1960 by 1897 pixels
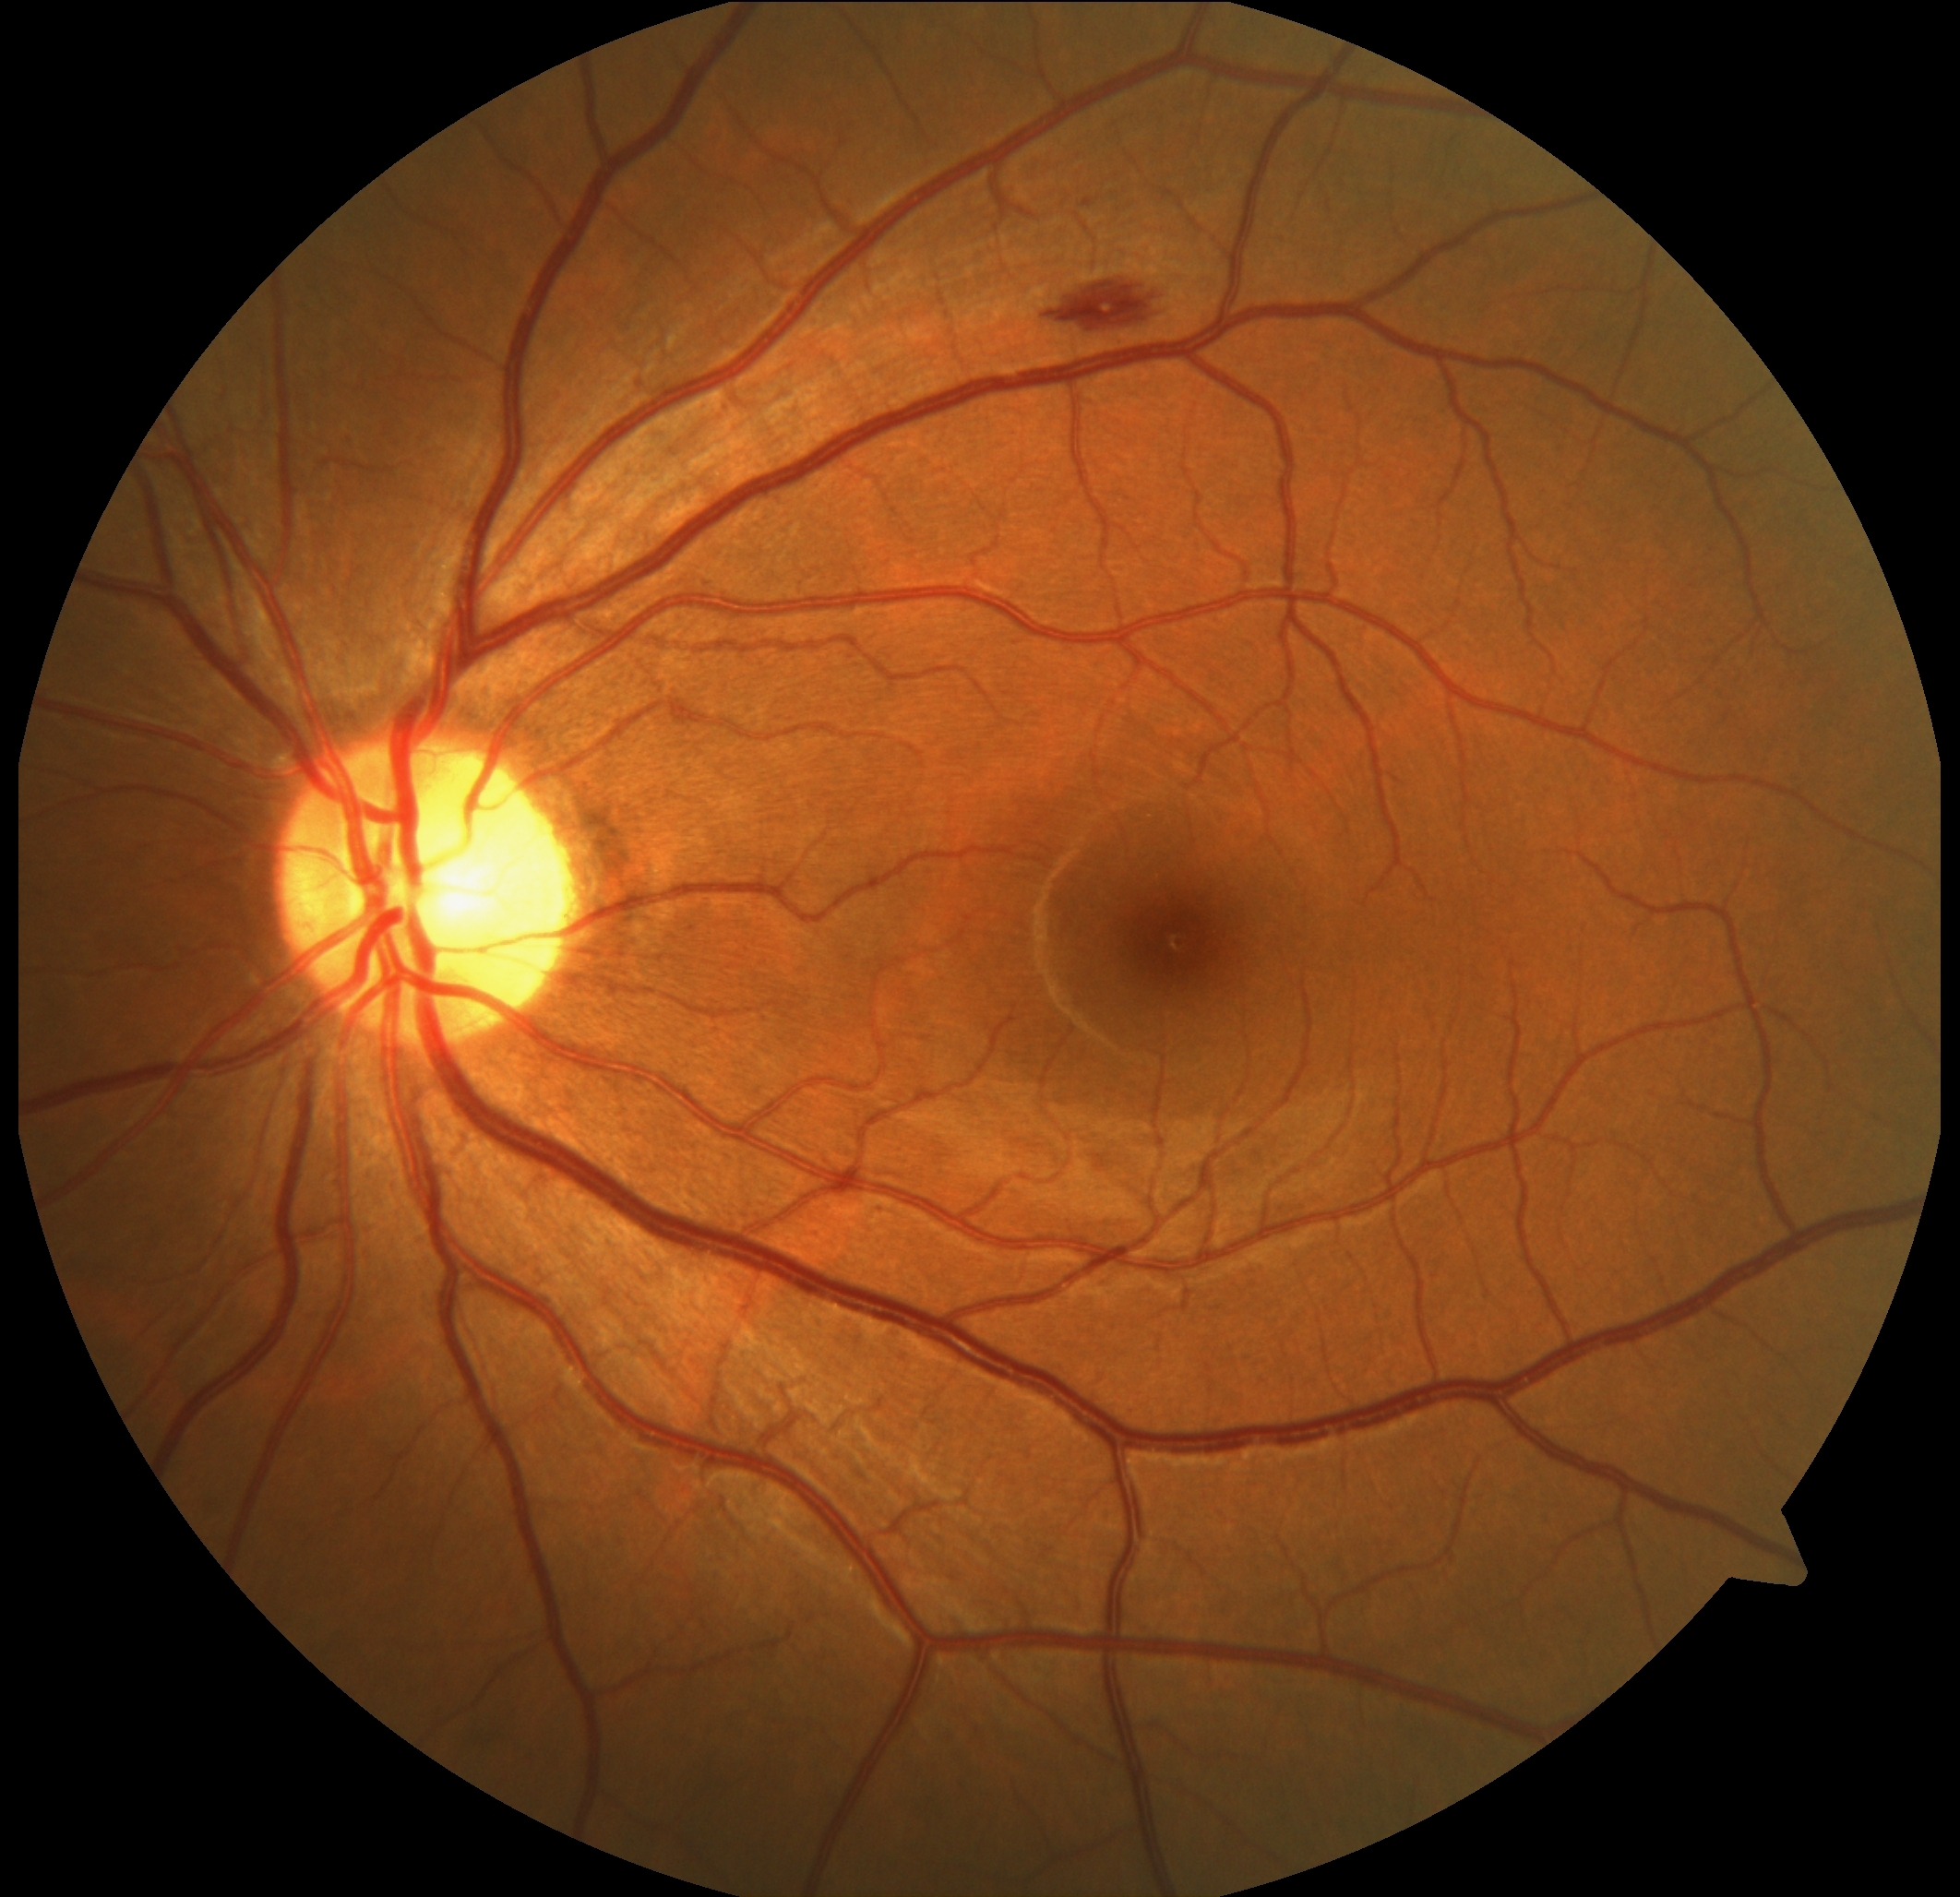 Diabetic retinopathy (DR) is grade 2.